848x848 · nonmydriatic · FOV: 45 degrees — 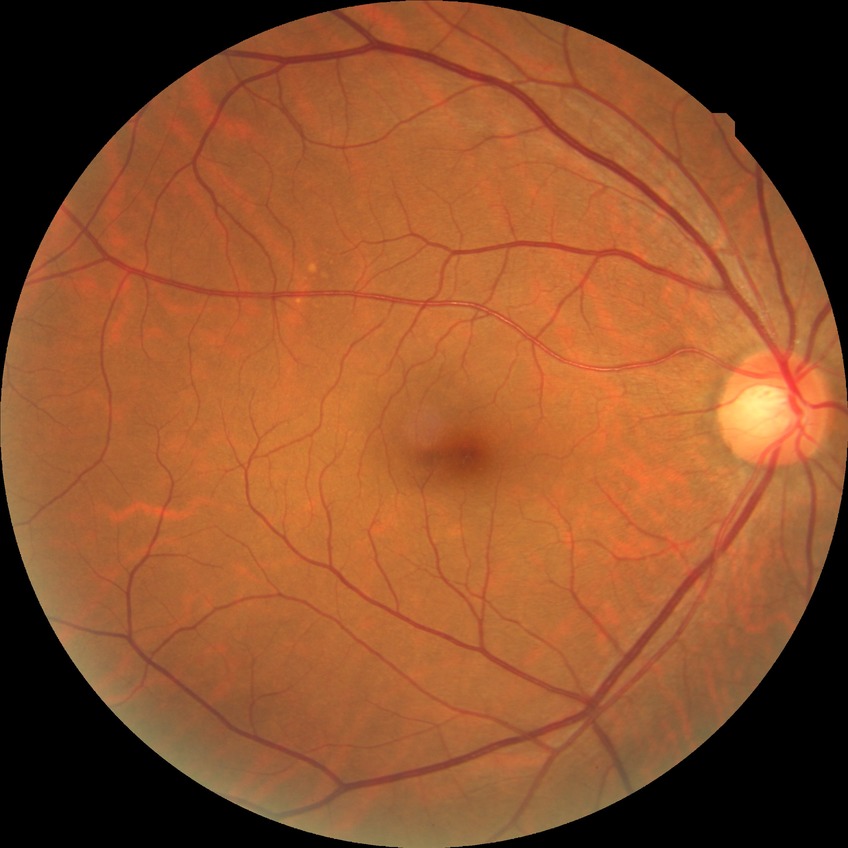
retinopathy stage@no diabetic retinopathy.